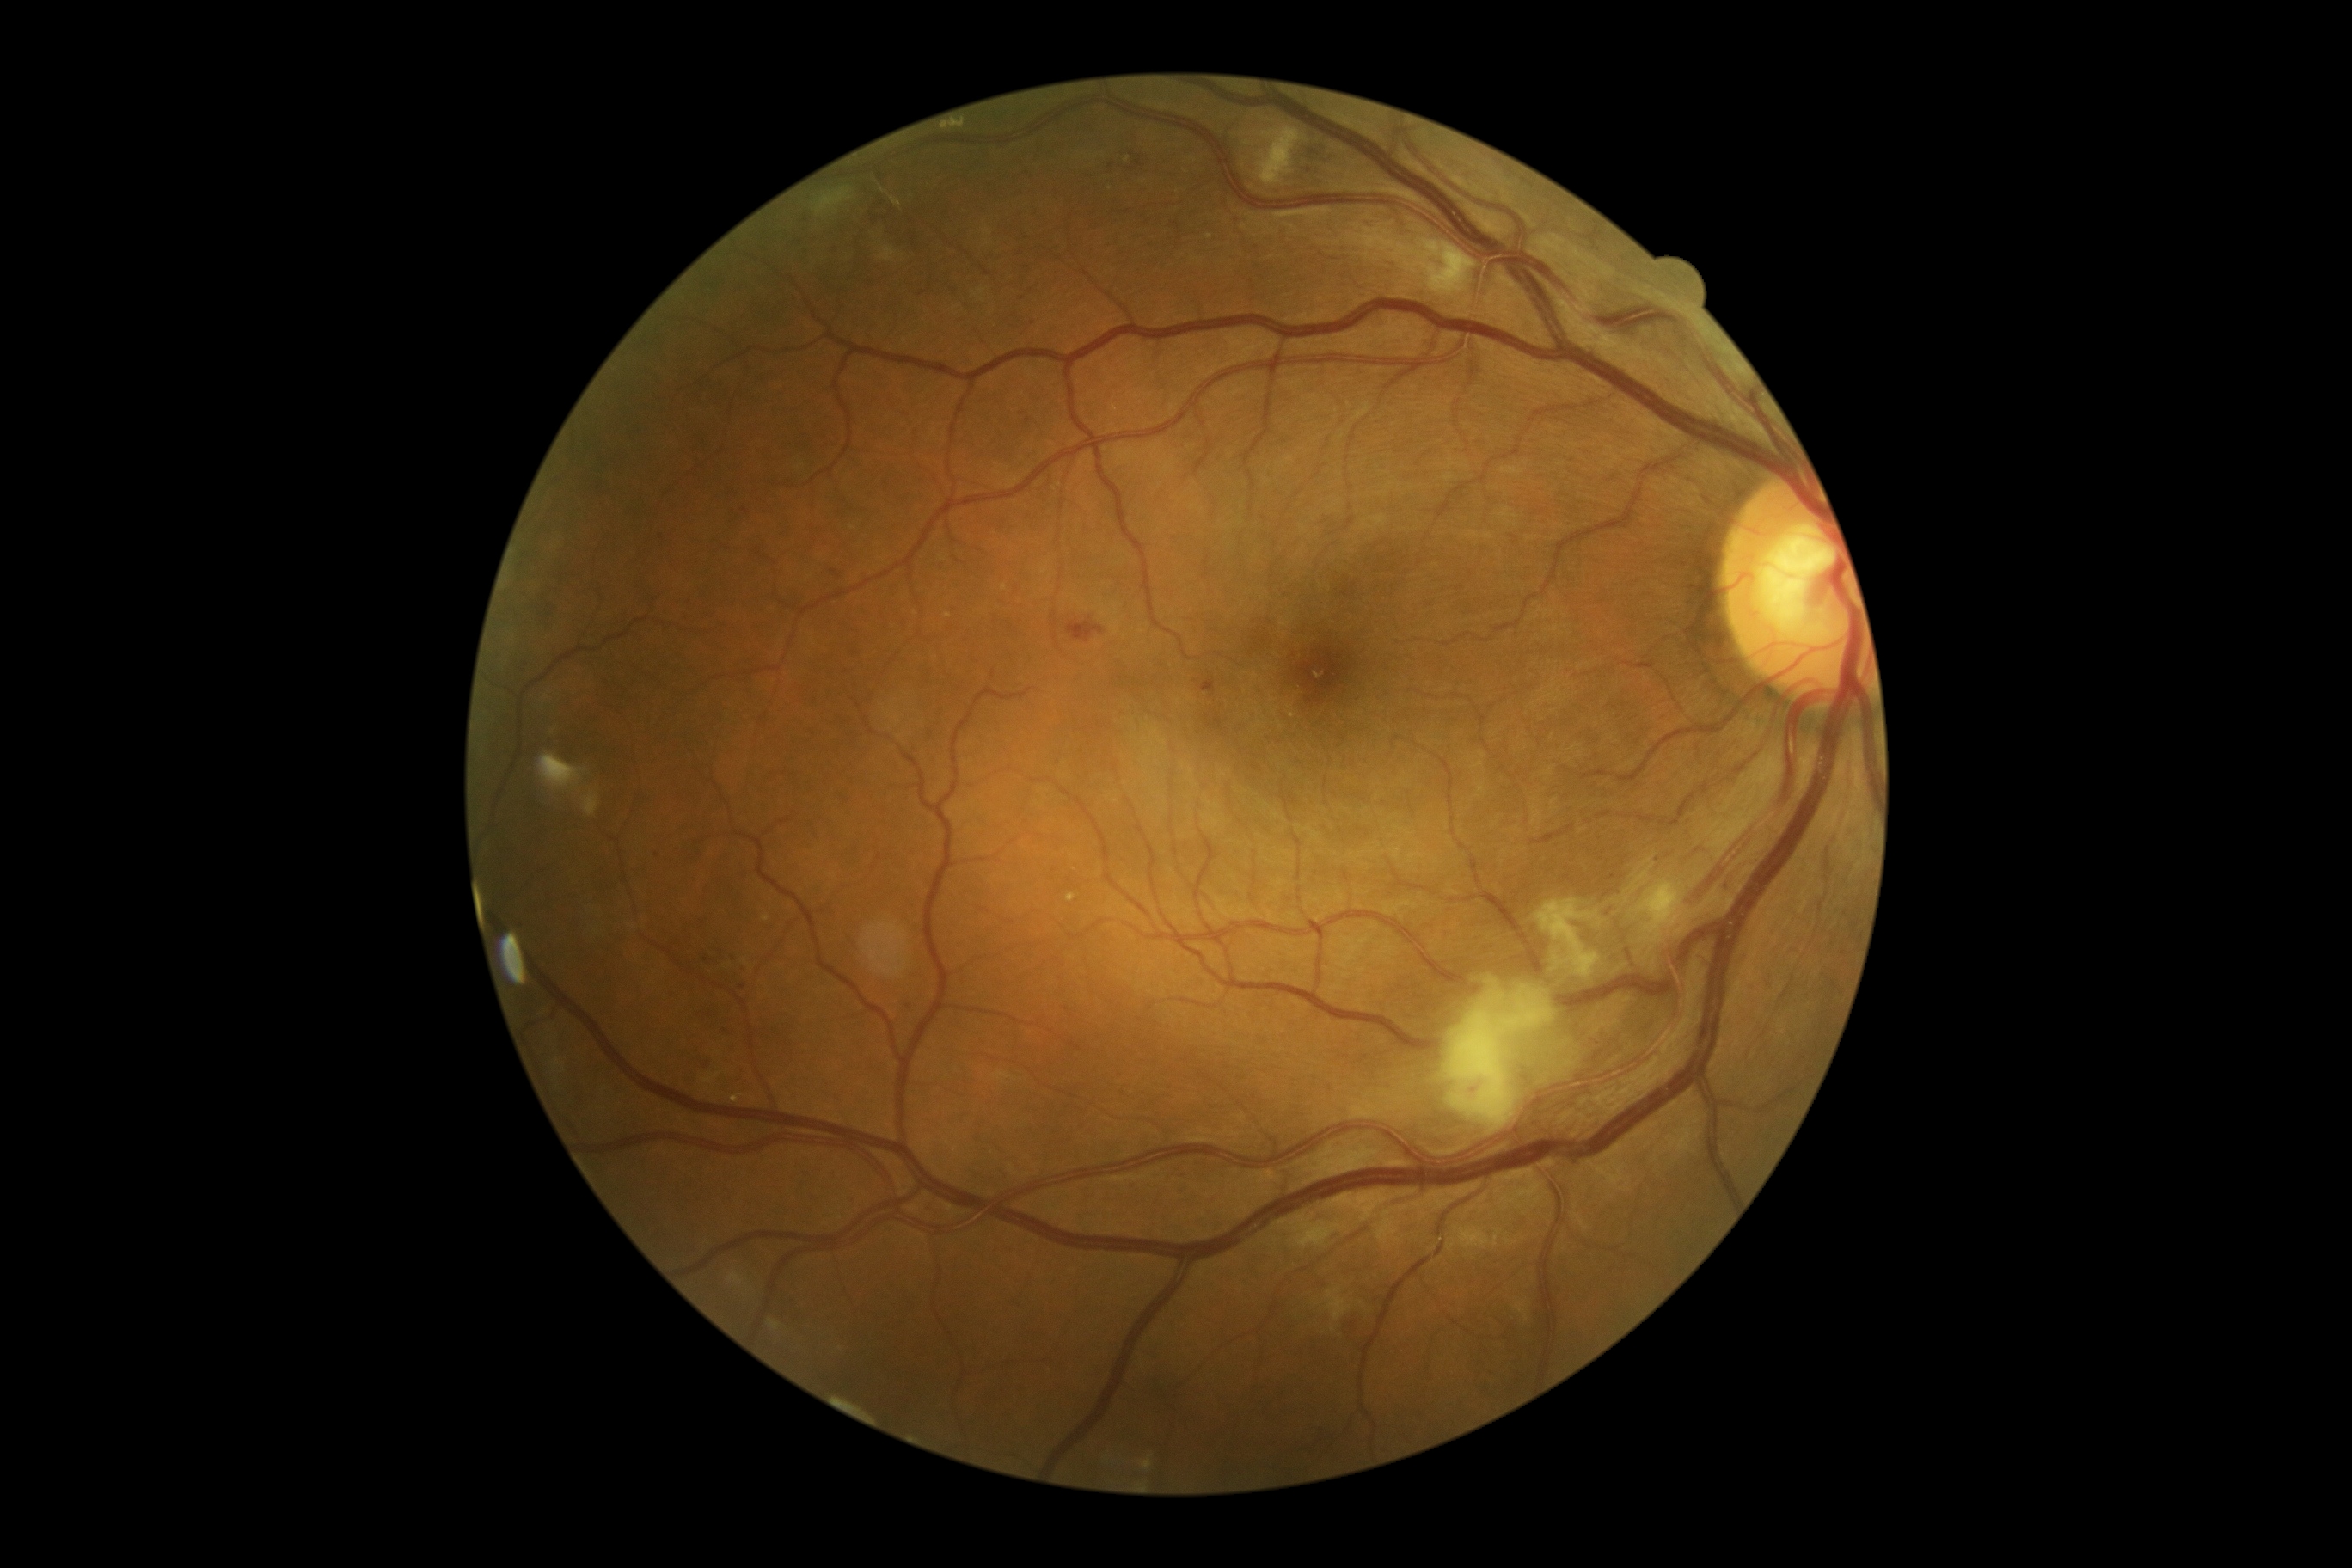
Diabetic retinopathy: severe NPDR (grade 3).
Disease class: non-proliferative diabetic retinopathy.